45° field of view: 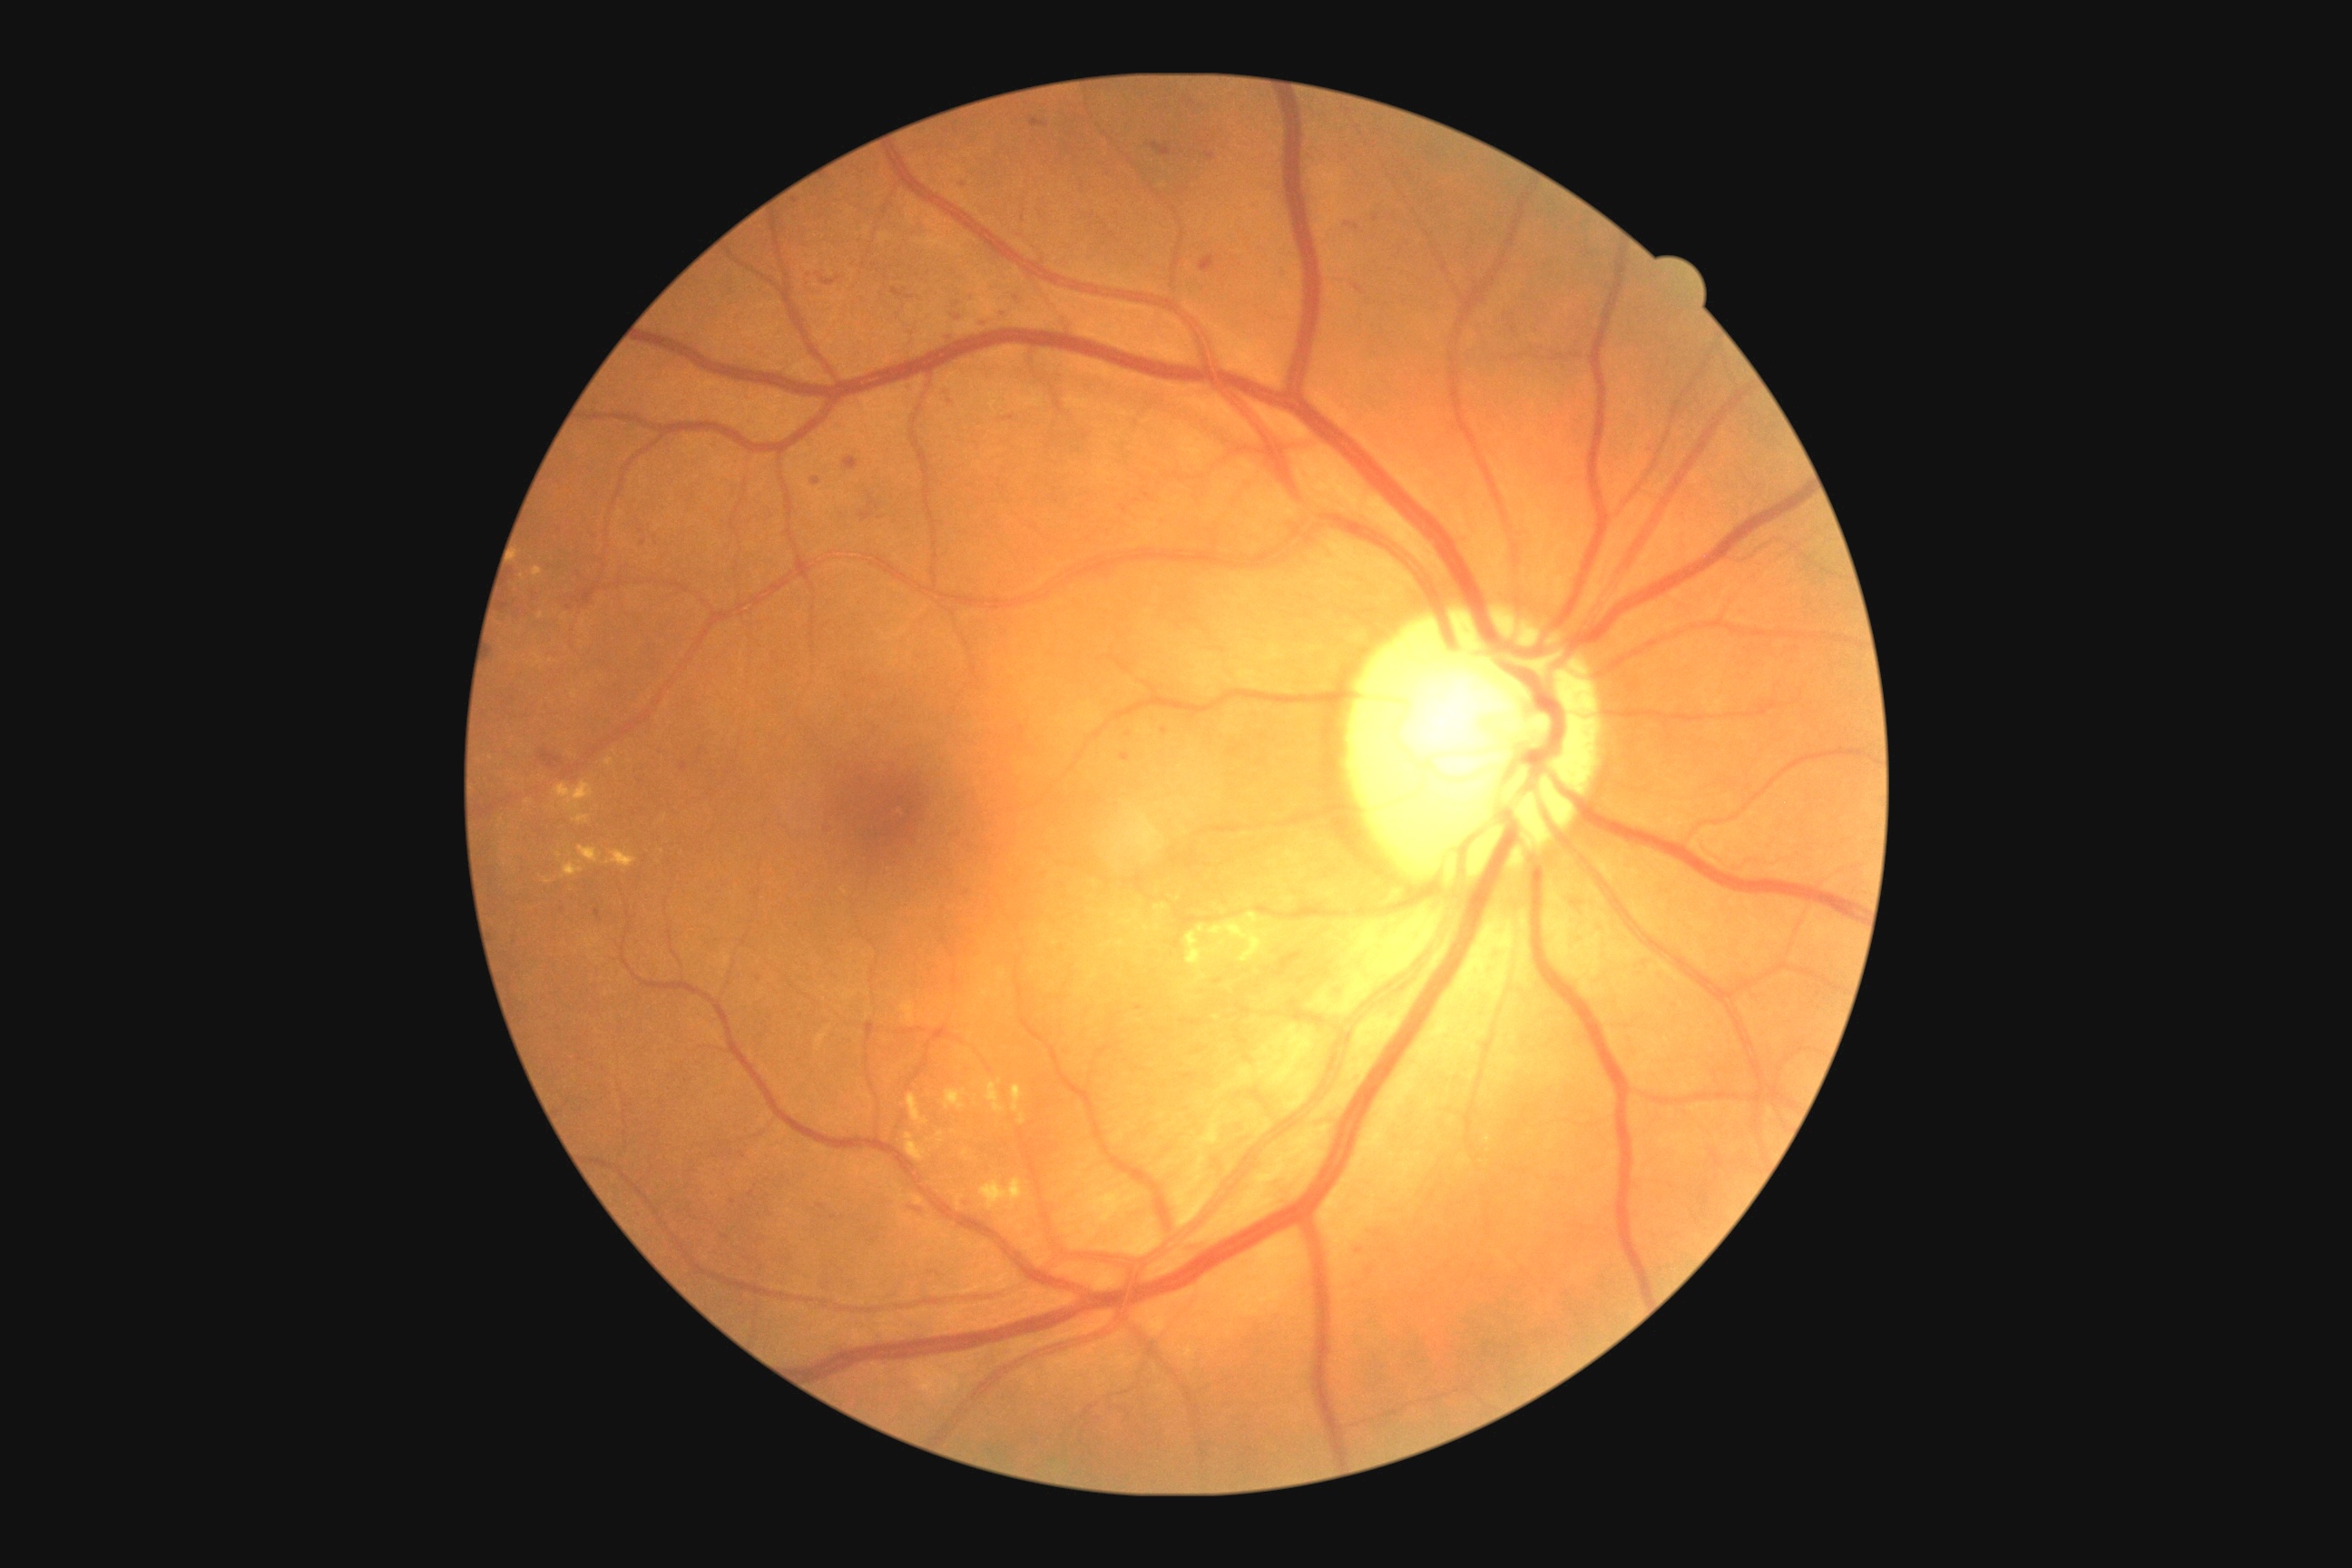 DR severity is grade 2; non-proliferative diabetic retinopathy. No MAs identified. No SEs identified. EXs include 906:1133:926:1162; 545:879:553:885; 1186:925:1217:968; 1210:914:1277:963; 945:1090:966:1112; 956:1195:965:1208; 985:1081:1006:1115; 574:816:589:825; 605:760:614:767; 1012:1084:1024:1112. Smaller EXs around 559, 856; 965, 1153. HEs include 812:478:821:485; 941:389:956:406; 859:495:881:522; 1355:286:1364:295; 892:288:905:297; 943:289:979:326; 1008:291:1023:304; 1200:257:1217:273; 1179:1239:1210:1255; 681:763:689:770. Smaller HEs around 1186, 101; 733, 1202; 644, 543; 821, 1207; 1192, 102; 569, 609; 1357, 228.